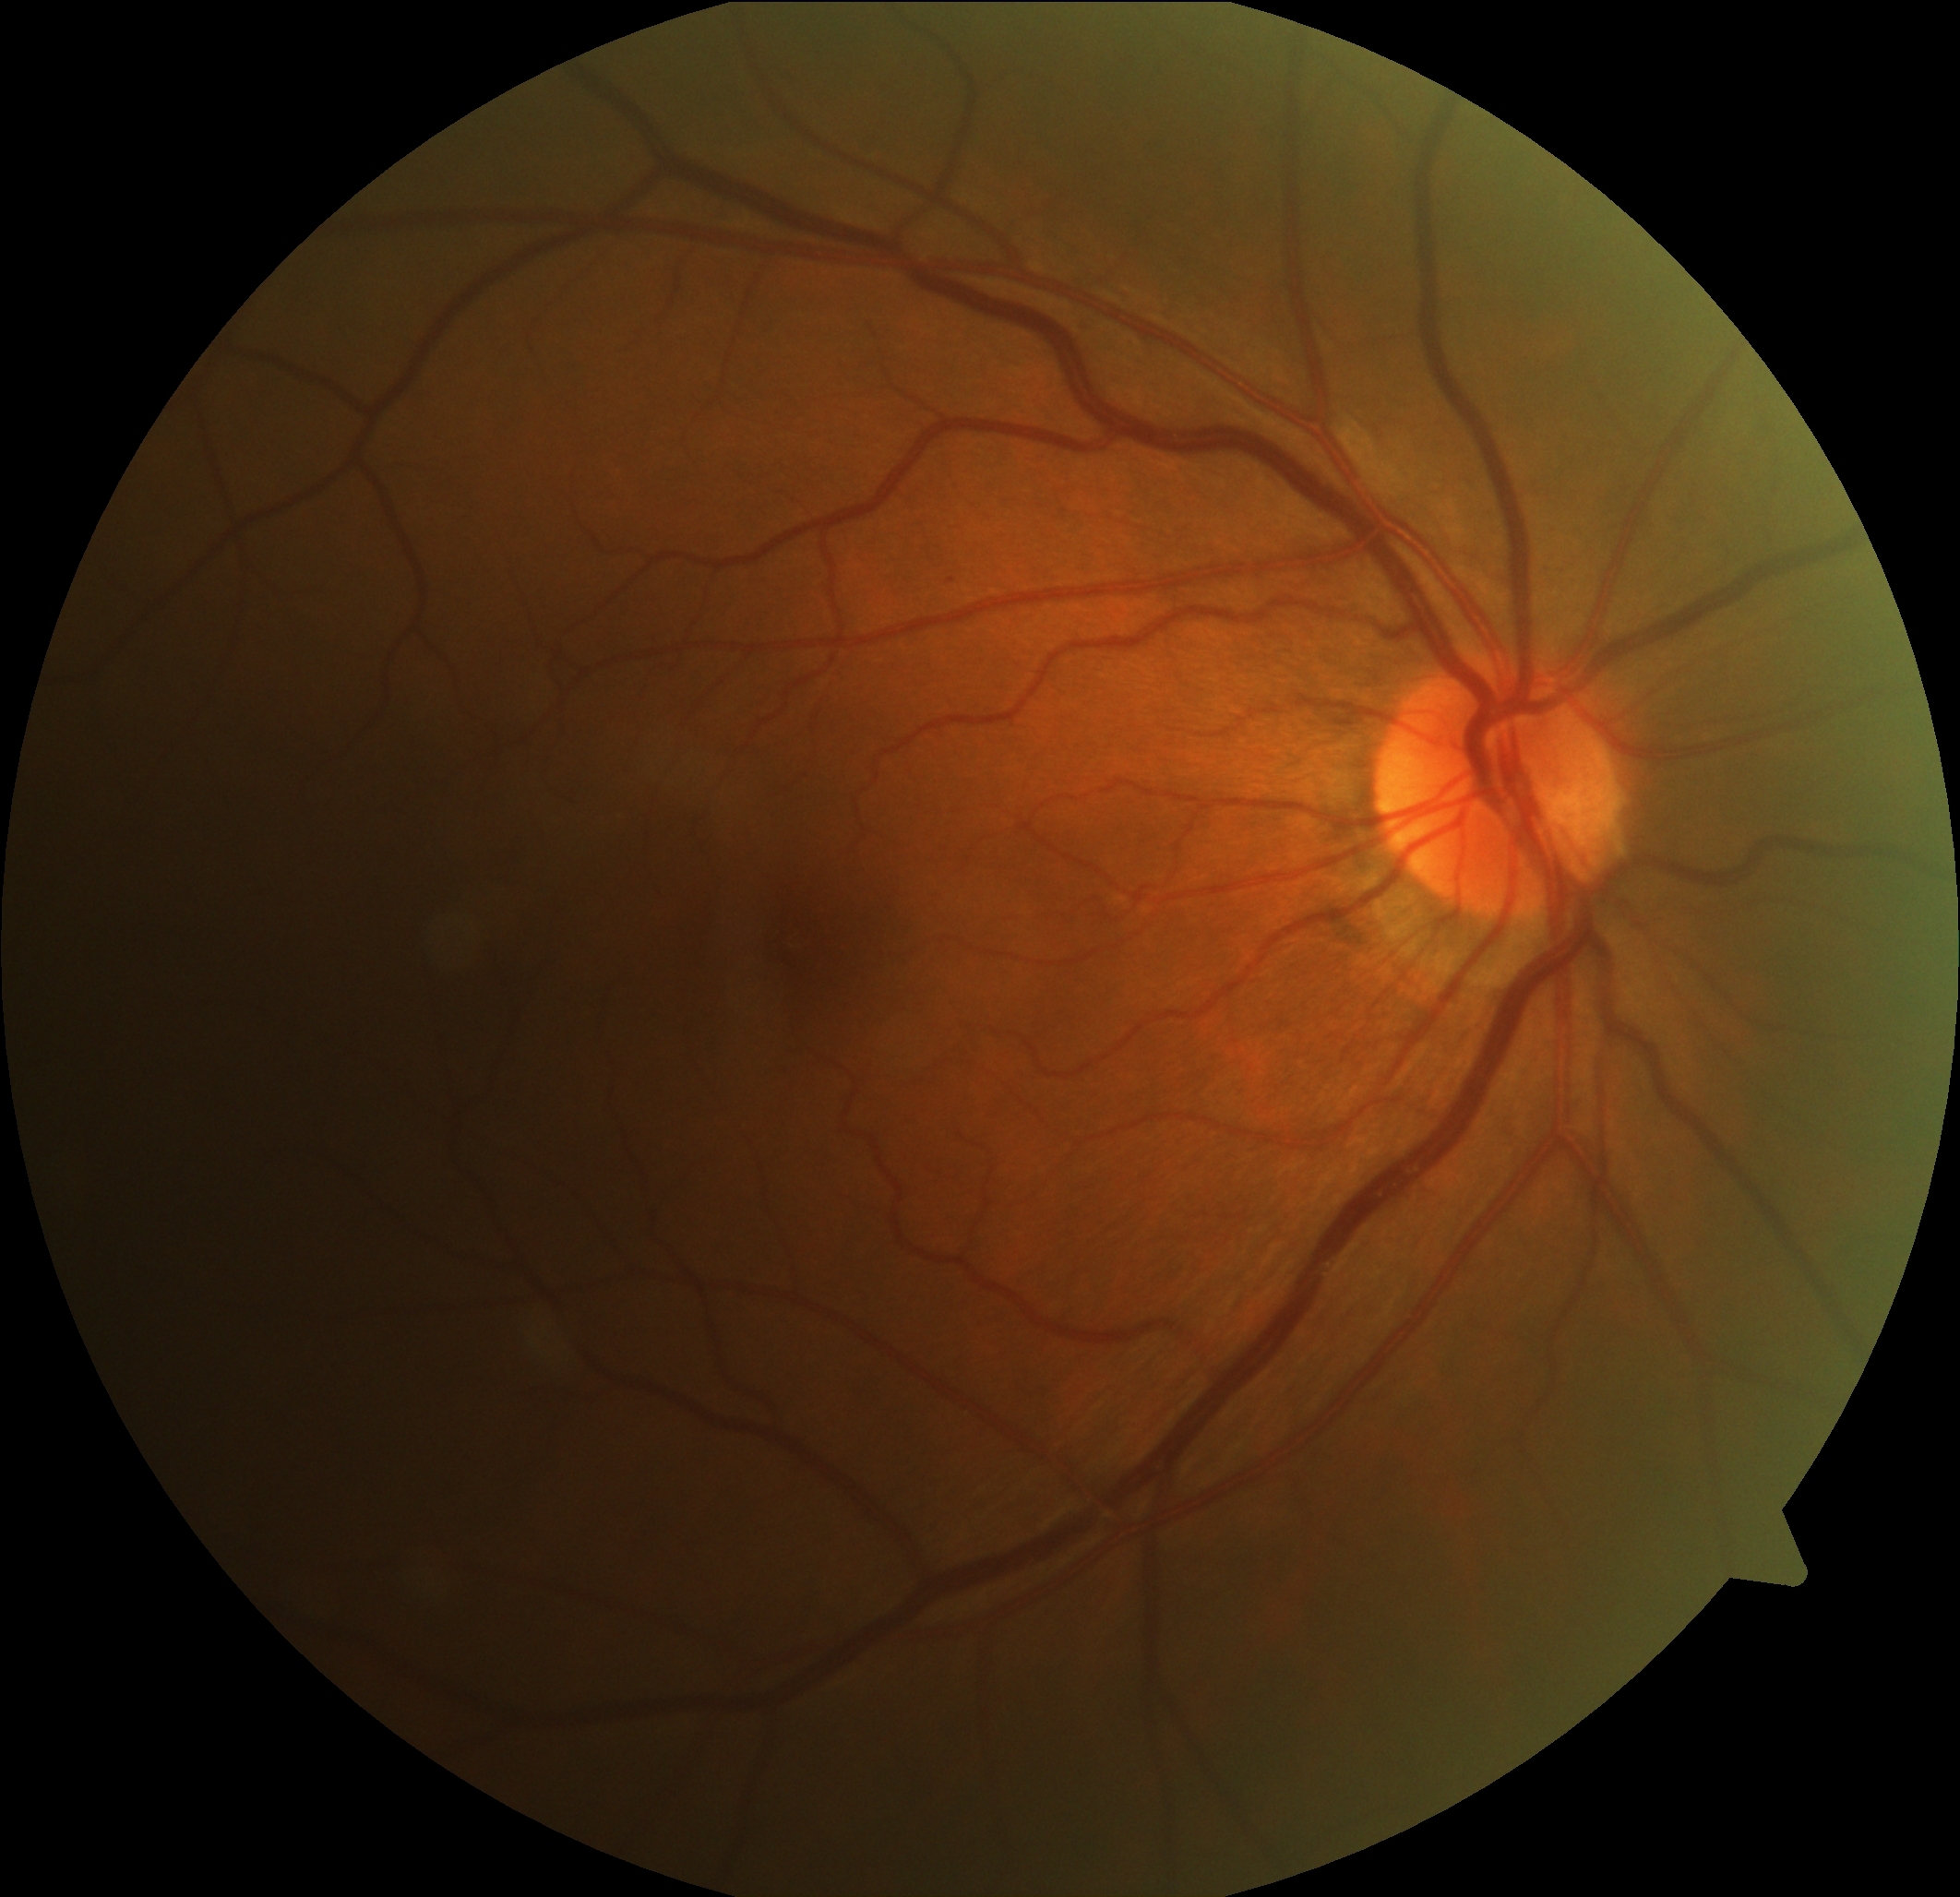   dr_grade: 1